Non-mydriatic fundus camera · 240 by 240 pixels
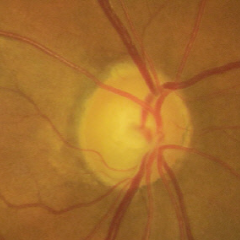 Q: What is the glaucoma diagnosis?
A: Early-stage glaucoma.